2352x1568.
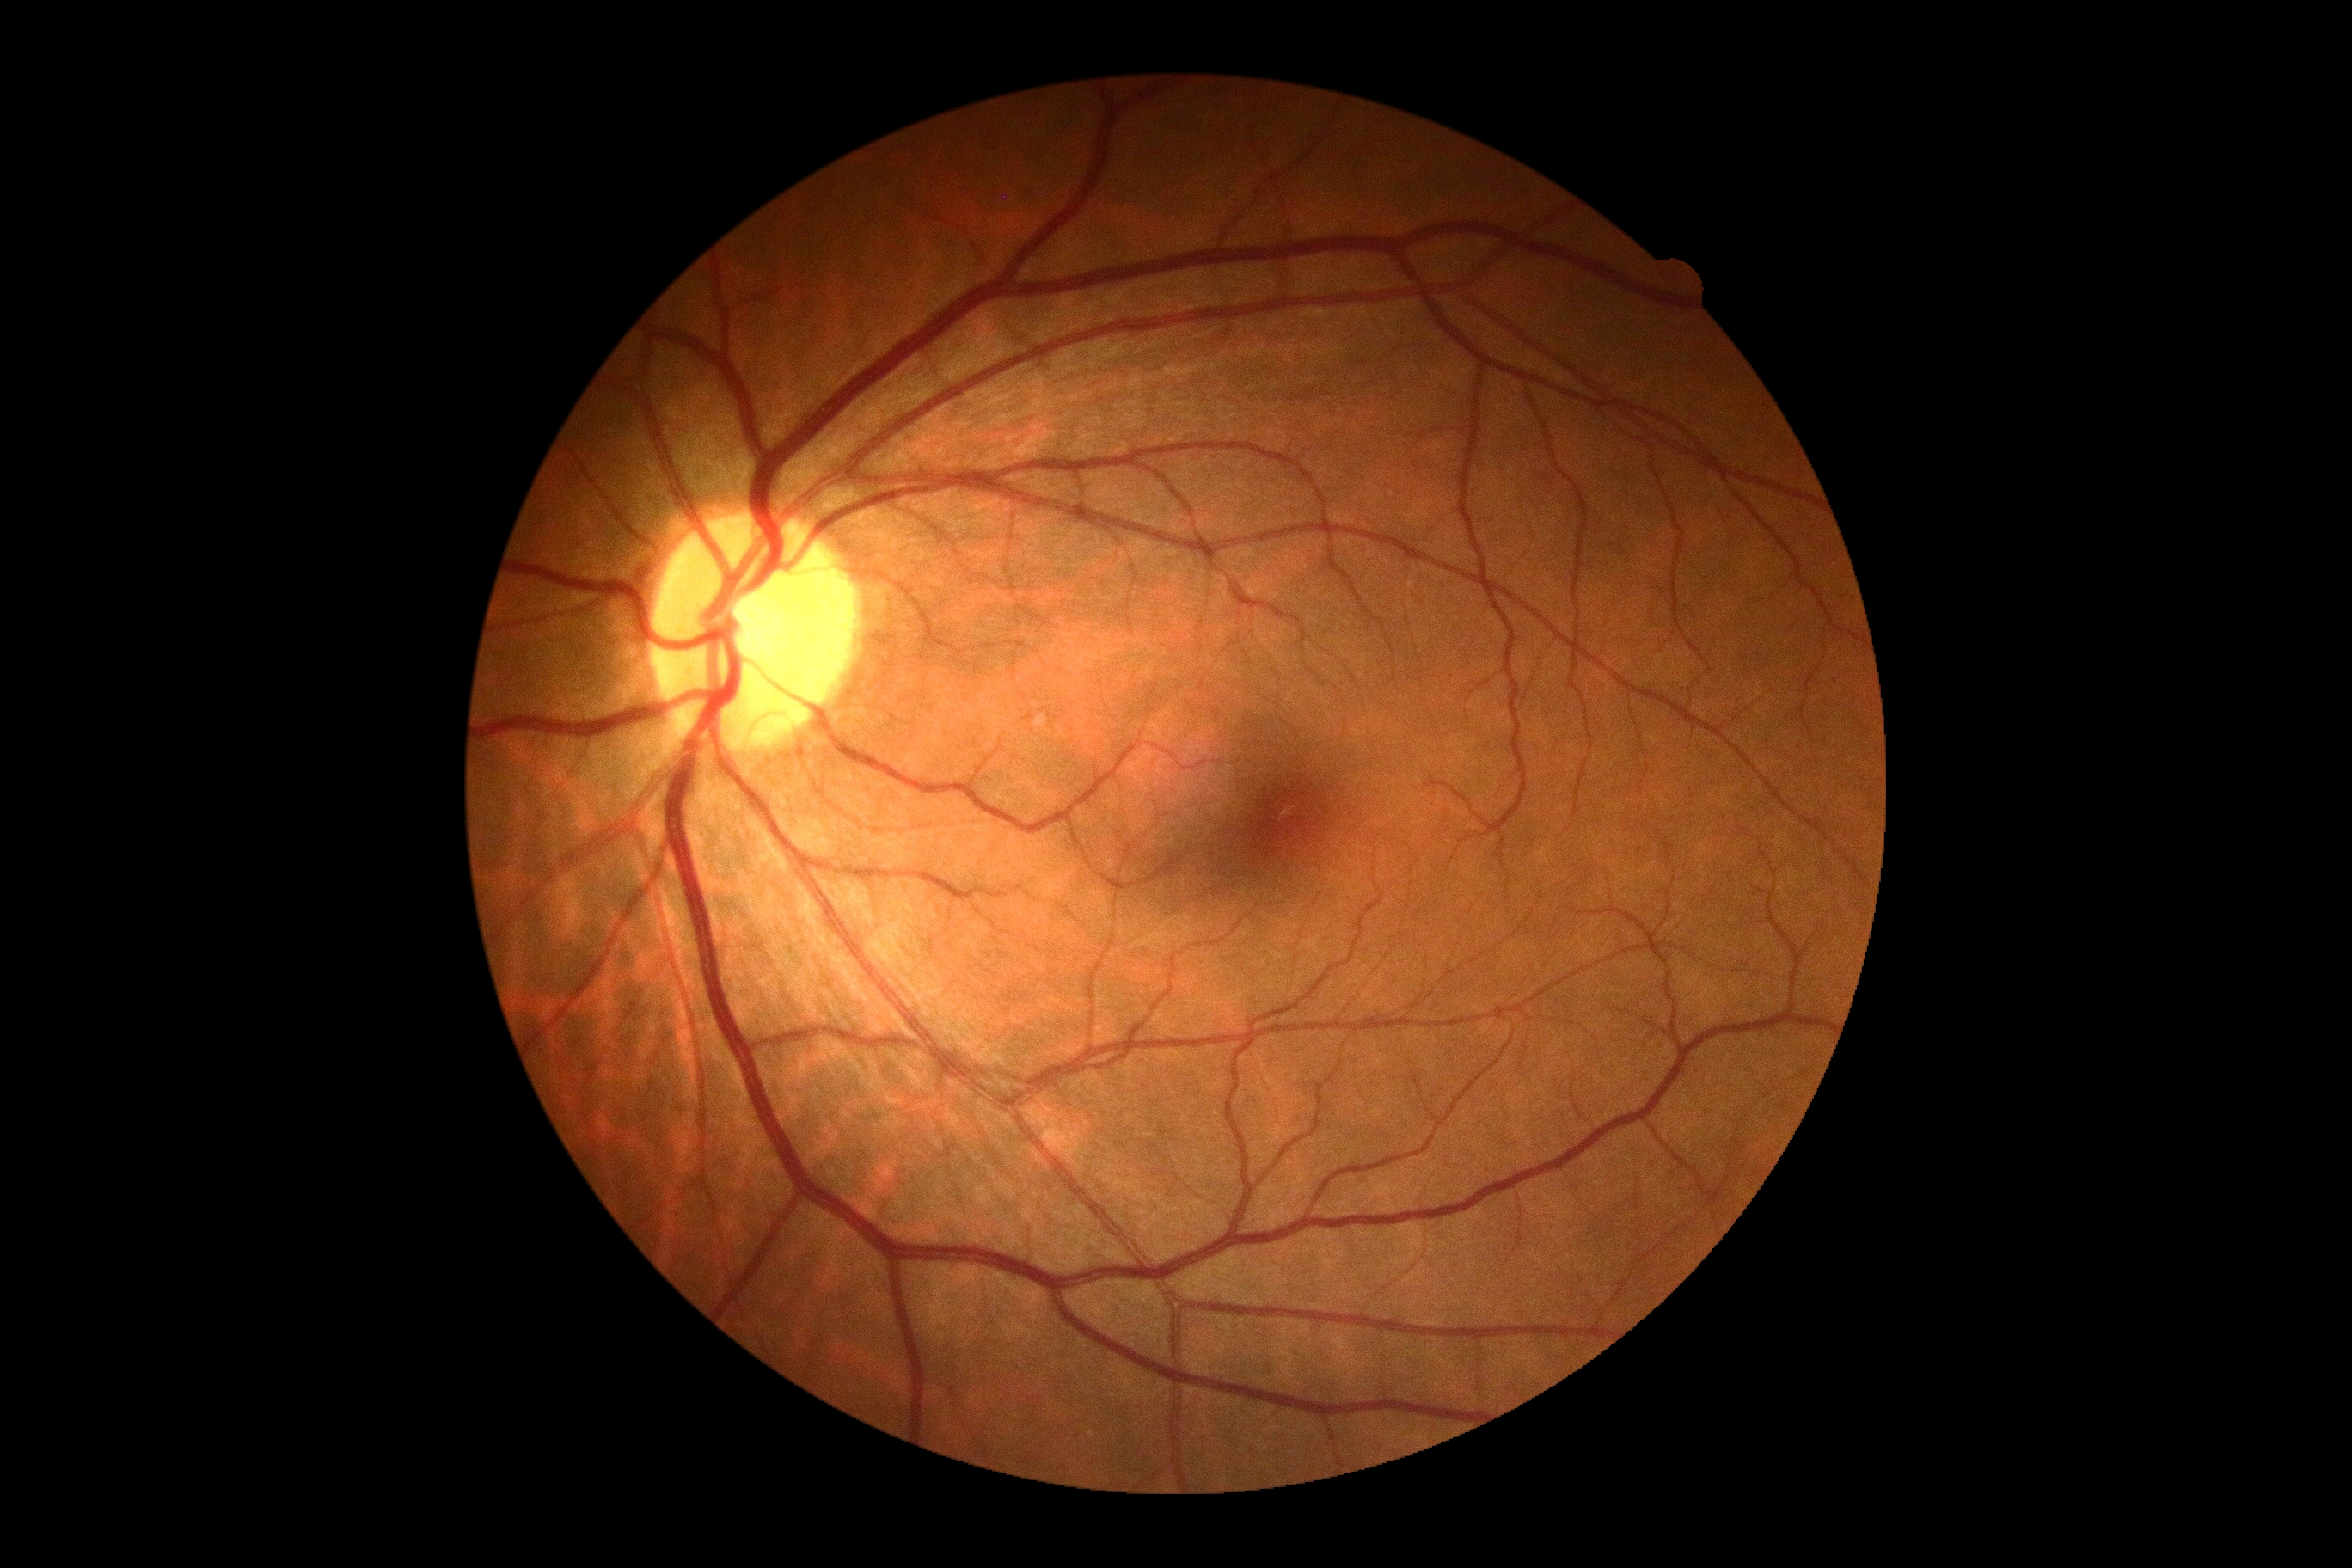
Diabetic retinopathy severity: 0/4. No DR findings.